Optic disc photograph:
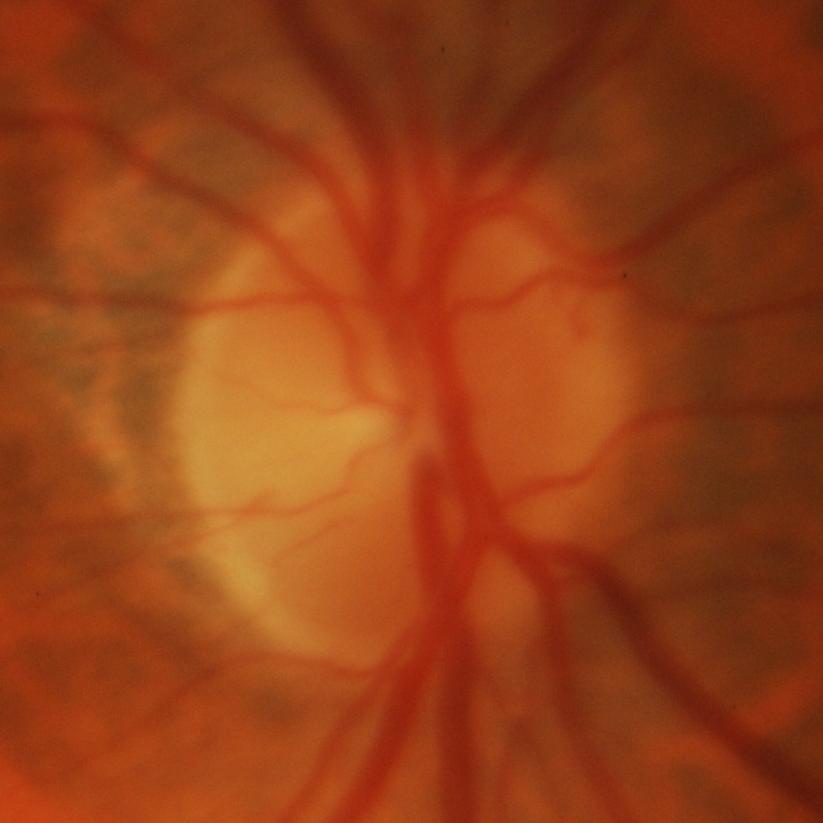
Glaucoma.